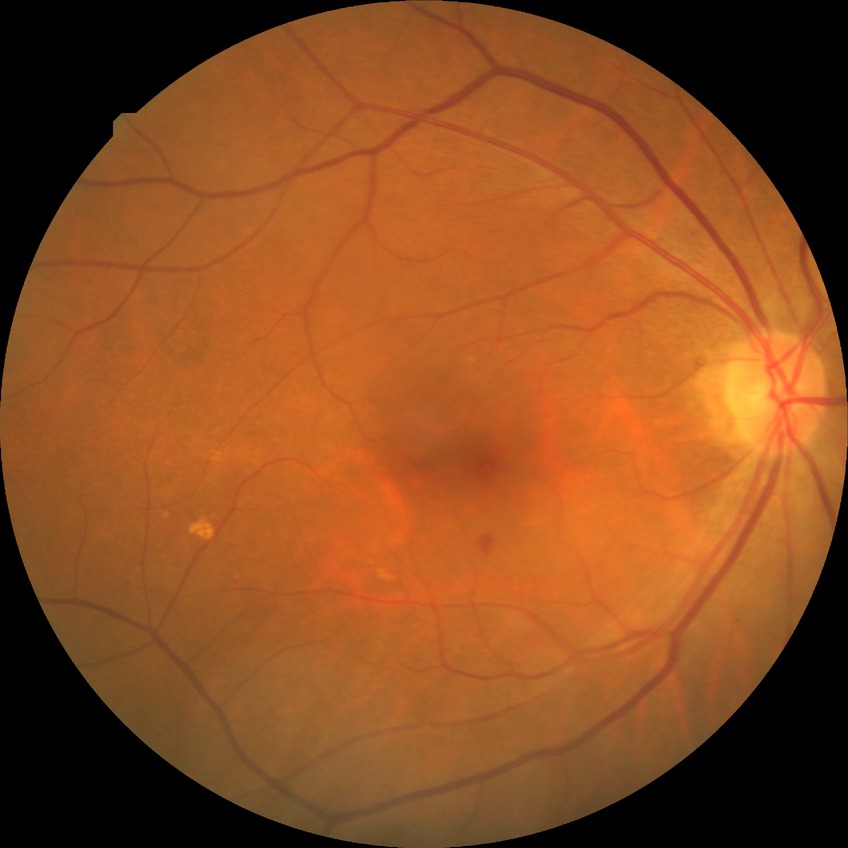 Diabetic retinopathy (DR): simple diabetic retinopathy (SDR).